Nonmydriatic fundus photograph; 848 by 848 pixels; retinal fundus photograph
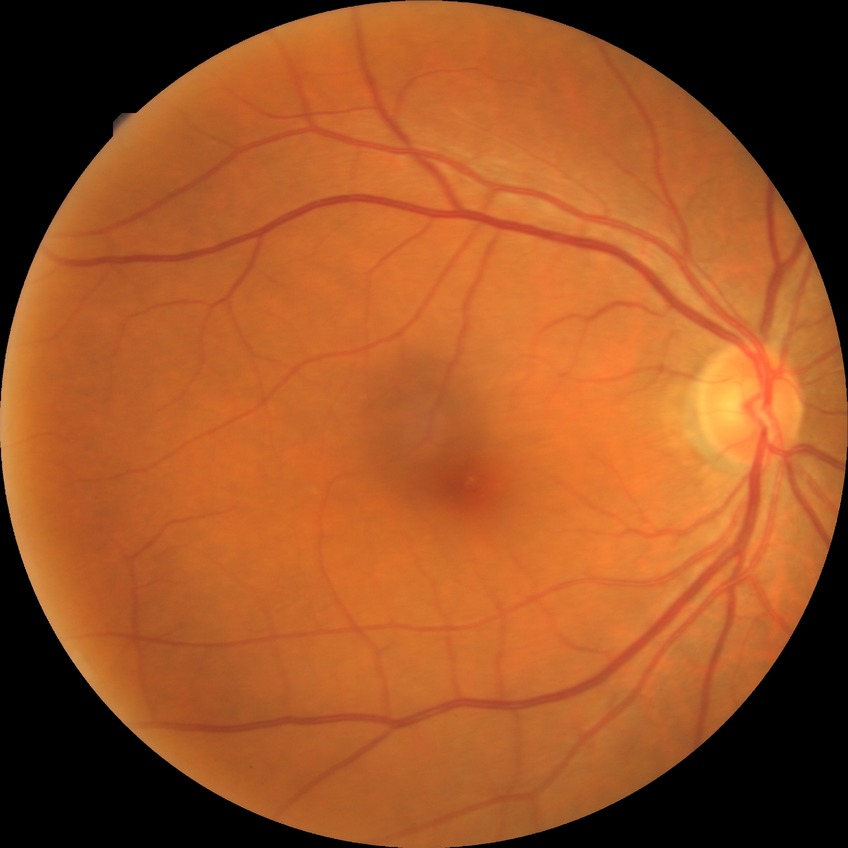

DR stage is NDR.